Graded on the modified Davis scale: 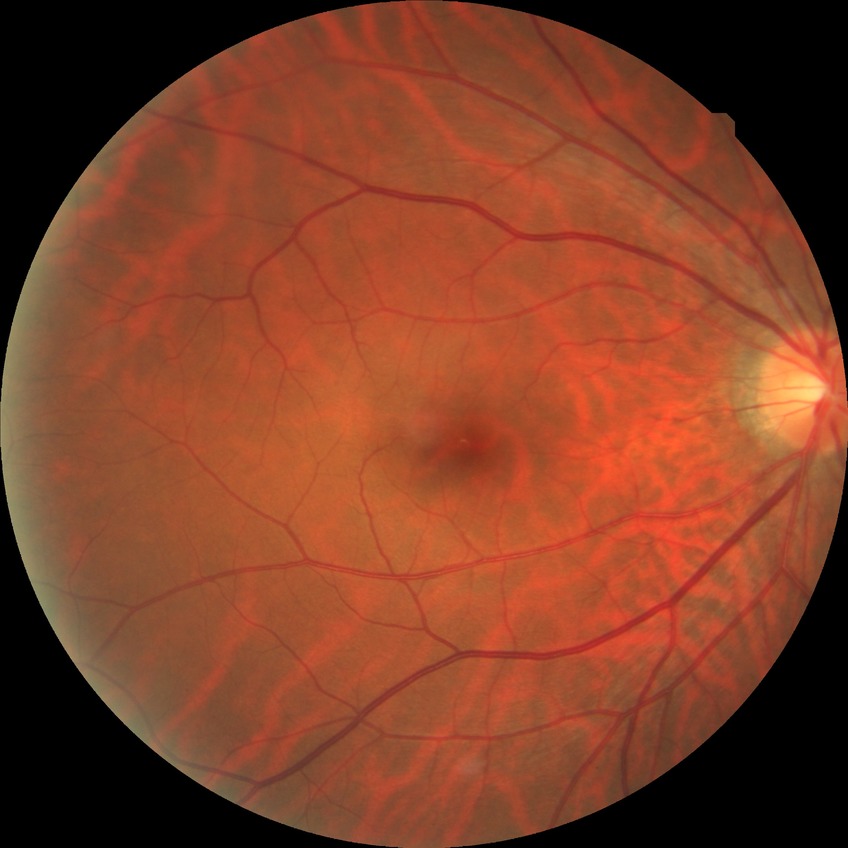
Modified Davis classification is no diabetic retinopathy.